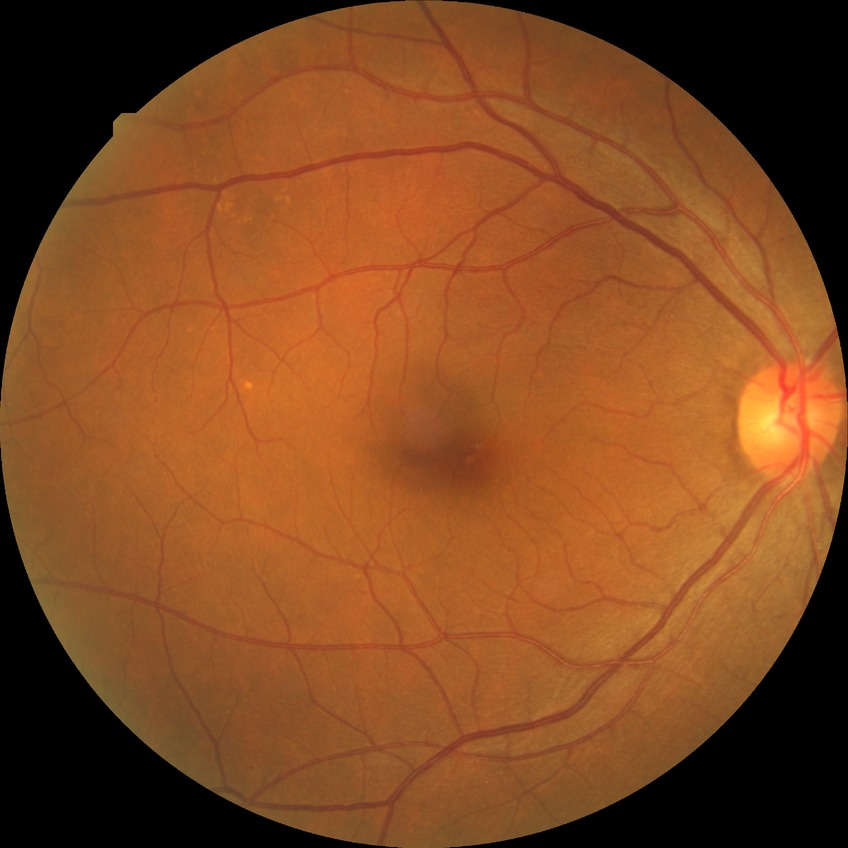 Diabetic retinopathy (DR): no diabetic retinopathy (NDR).